1240 x 1240 pixels · wide-field fundus photograph of an infant — 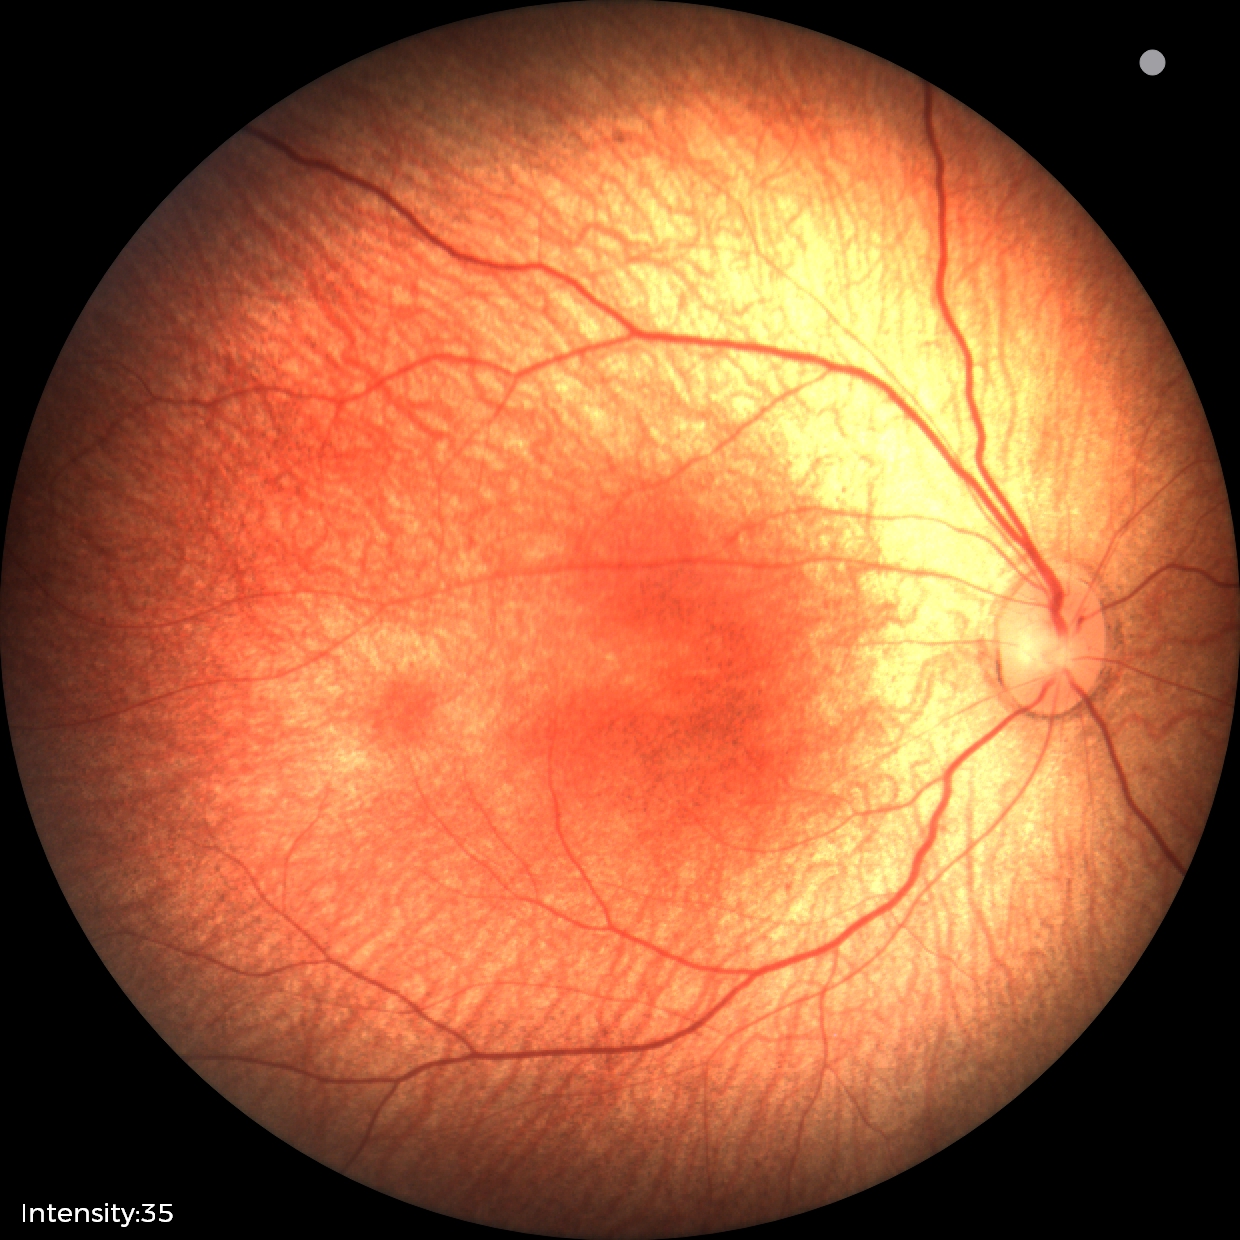
Q: What is the screening diagnosis?
A: physiological finding